NIDEK AFC-230 fundus camera.
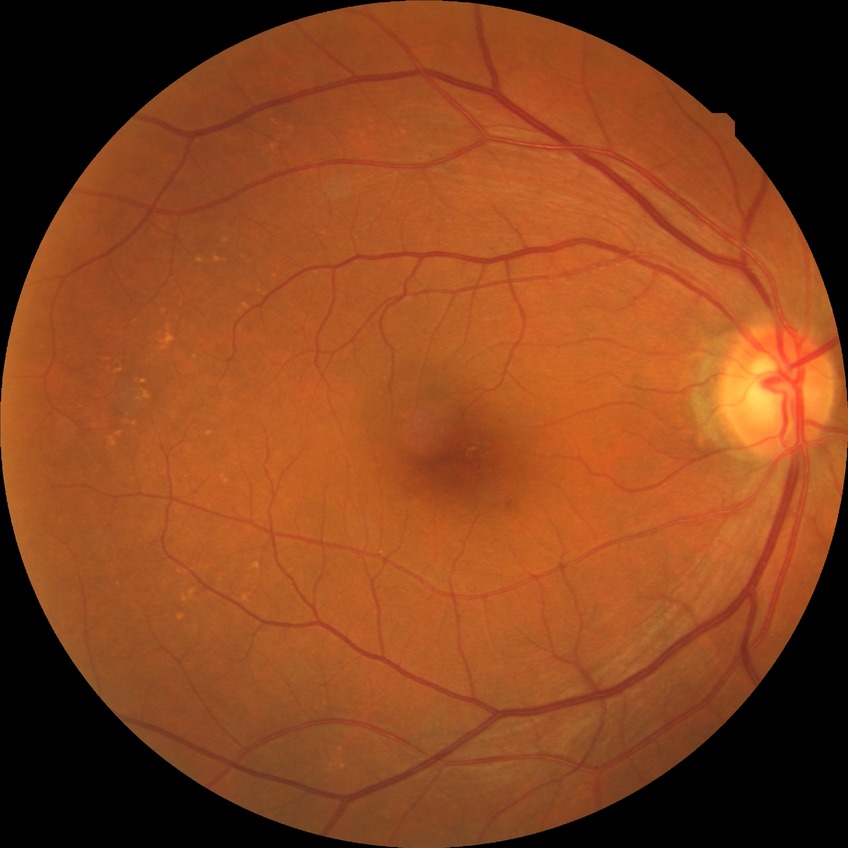 modified Davis grade = NDR